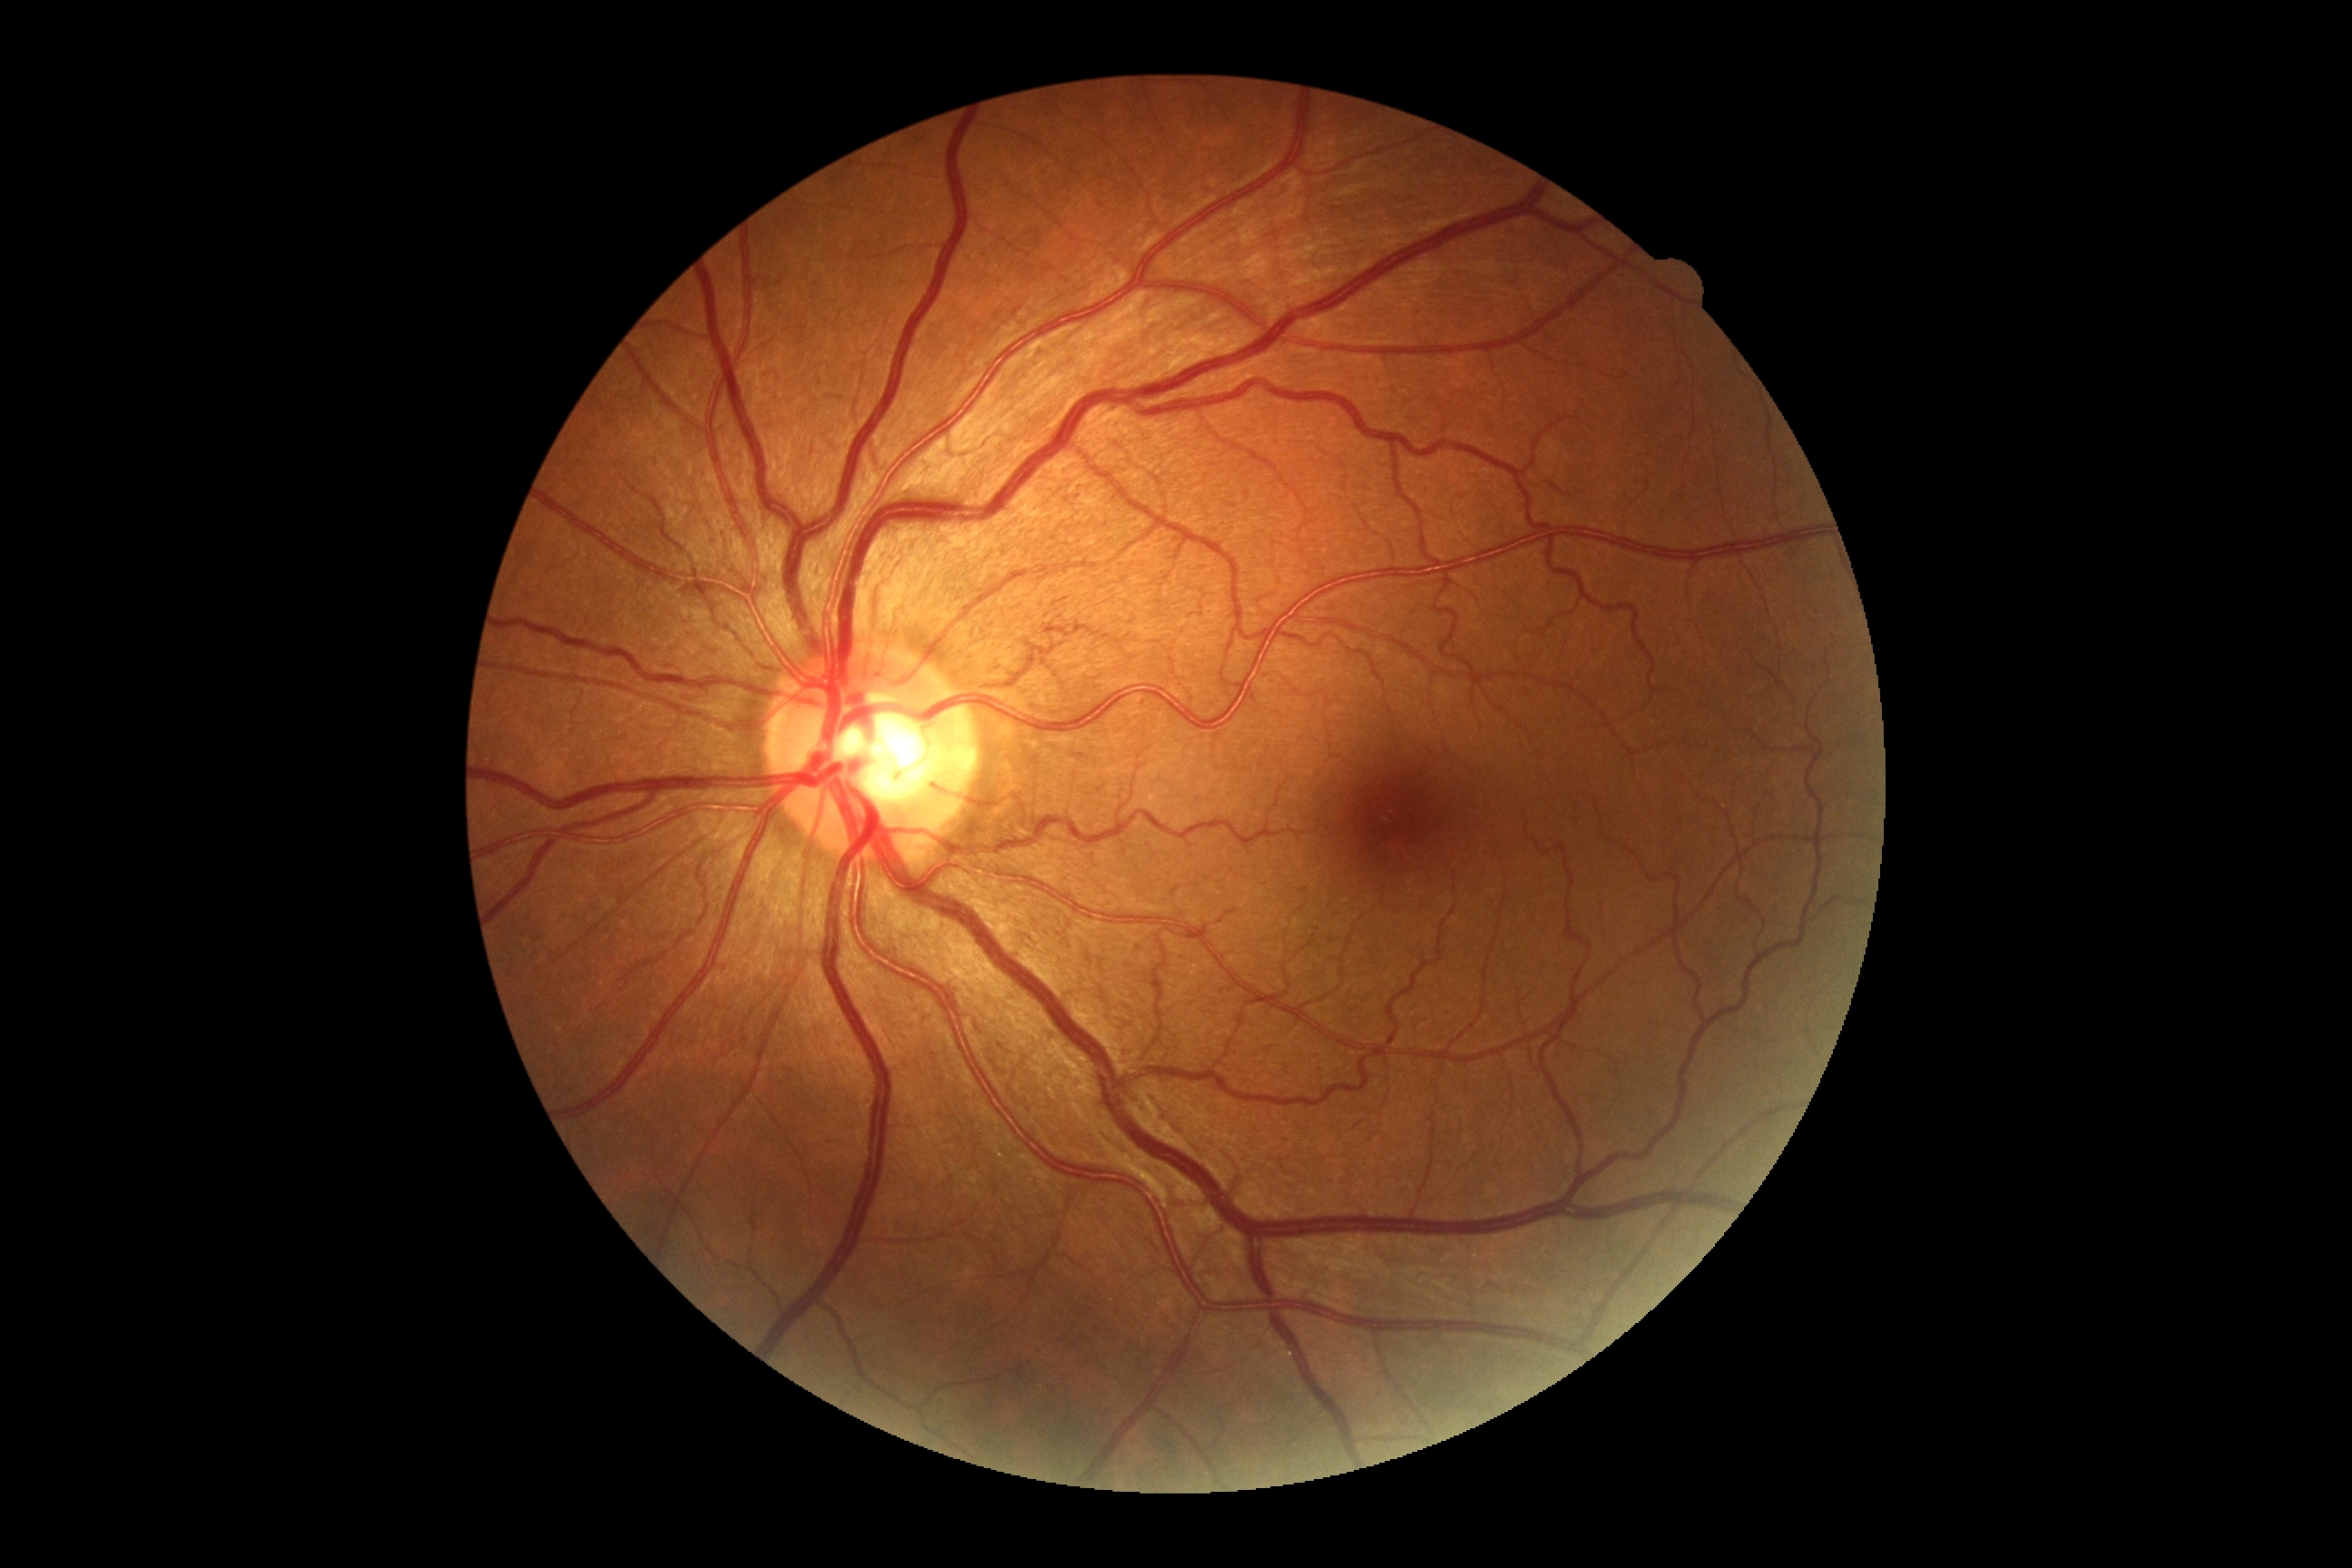
DR severity is grade 0.